Color fundus photograph: 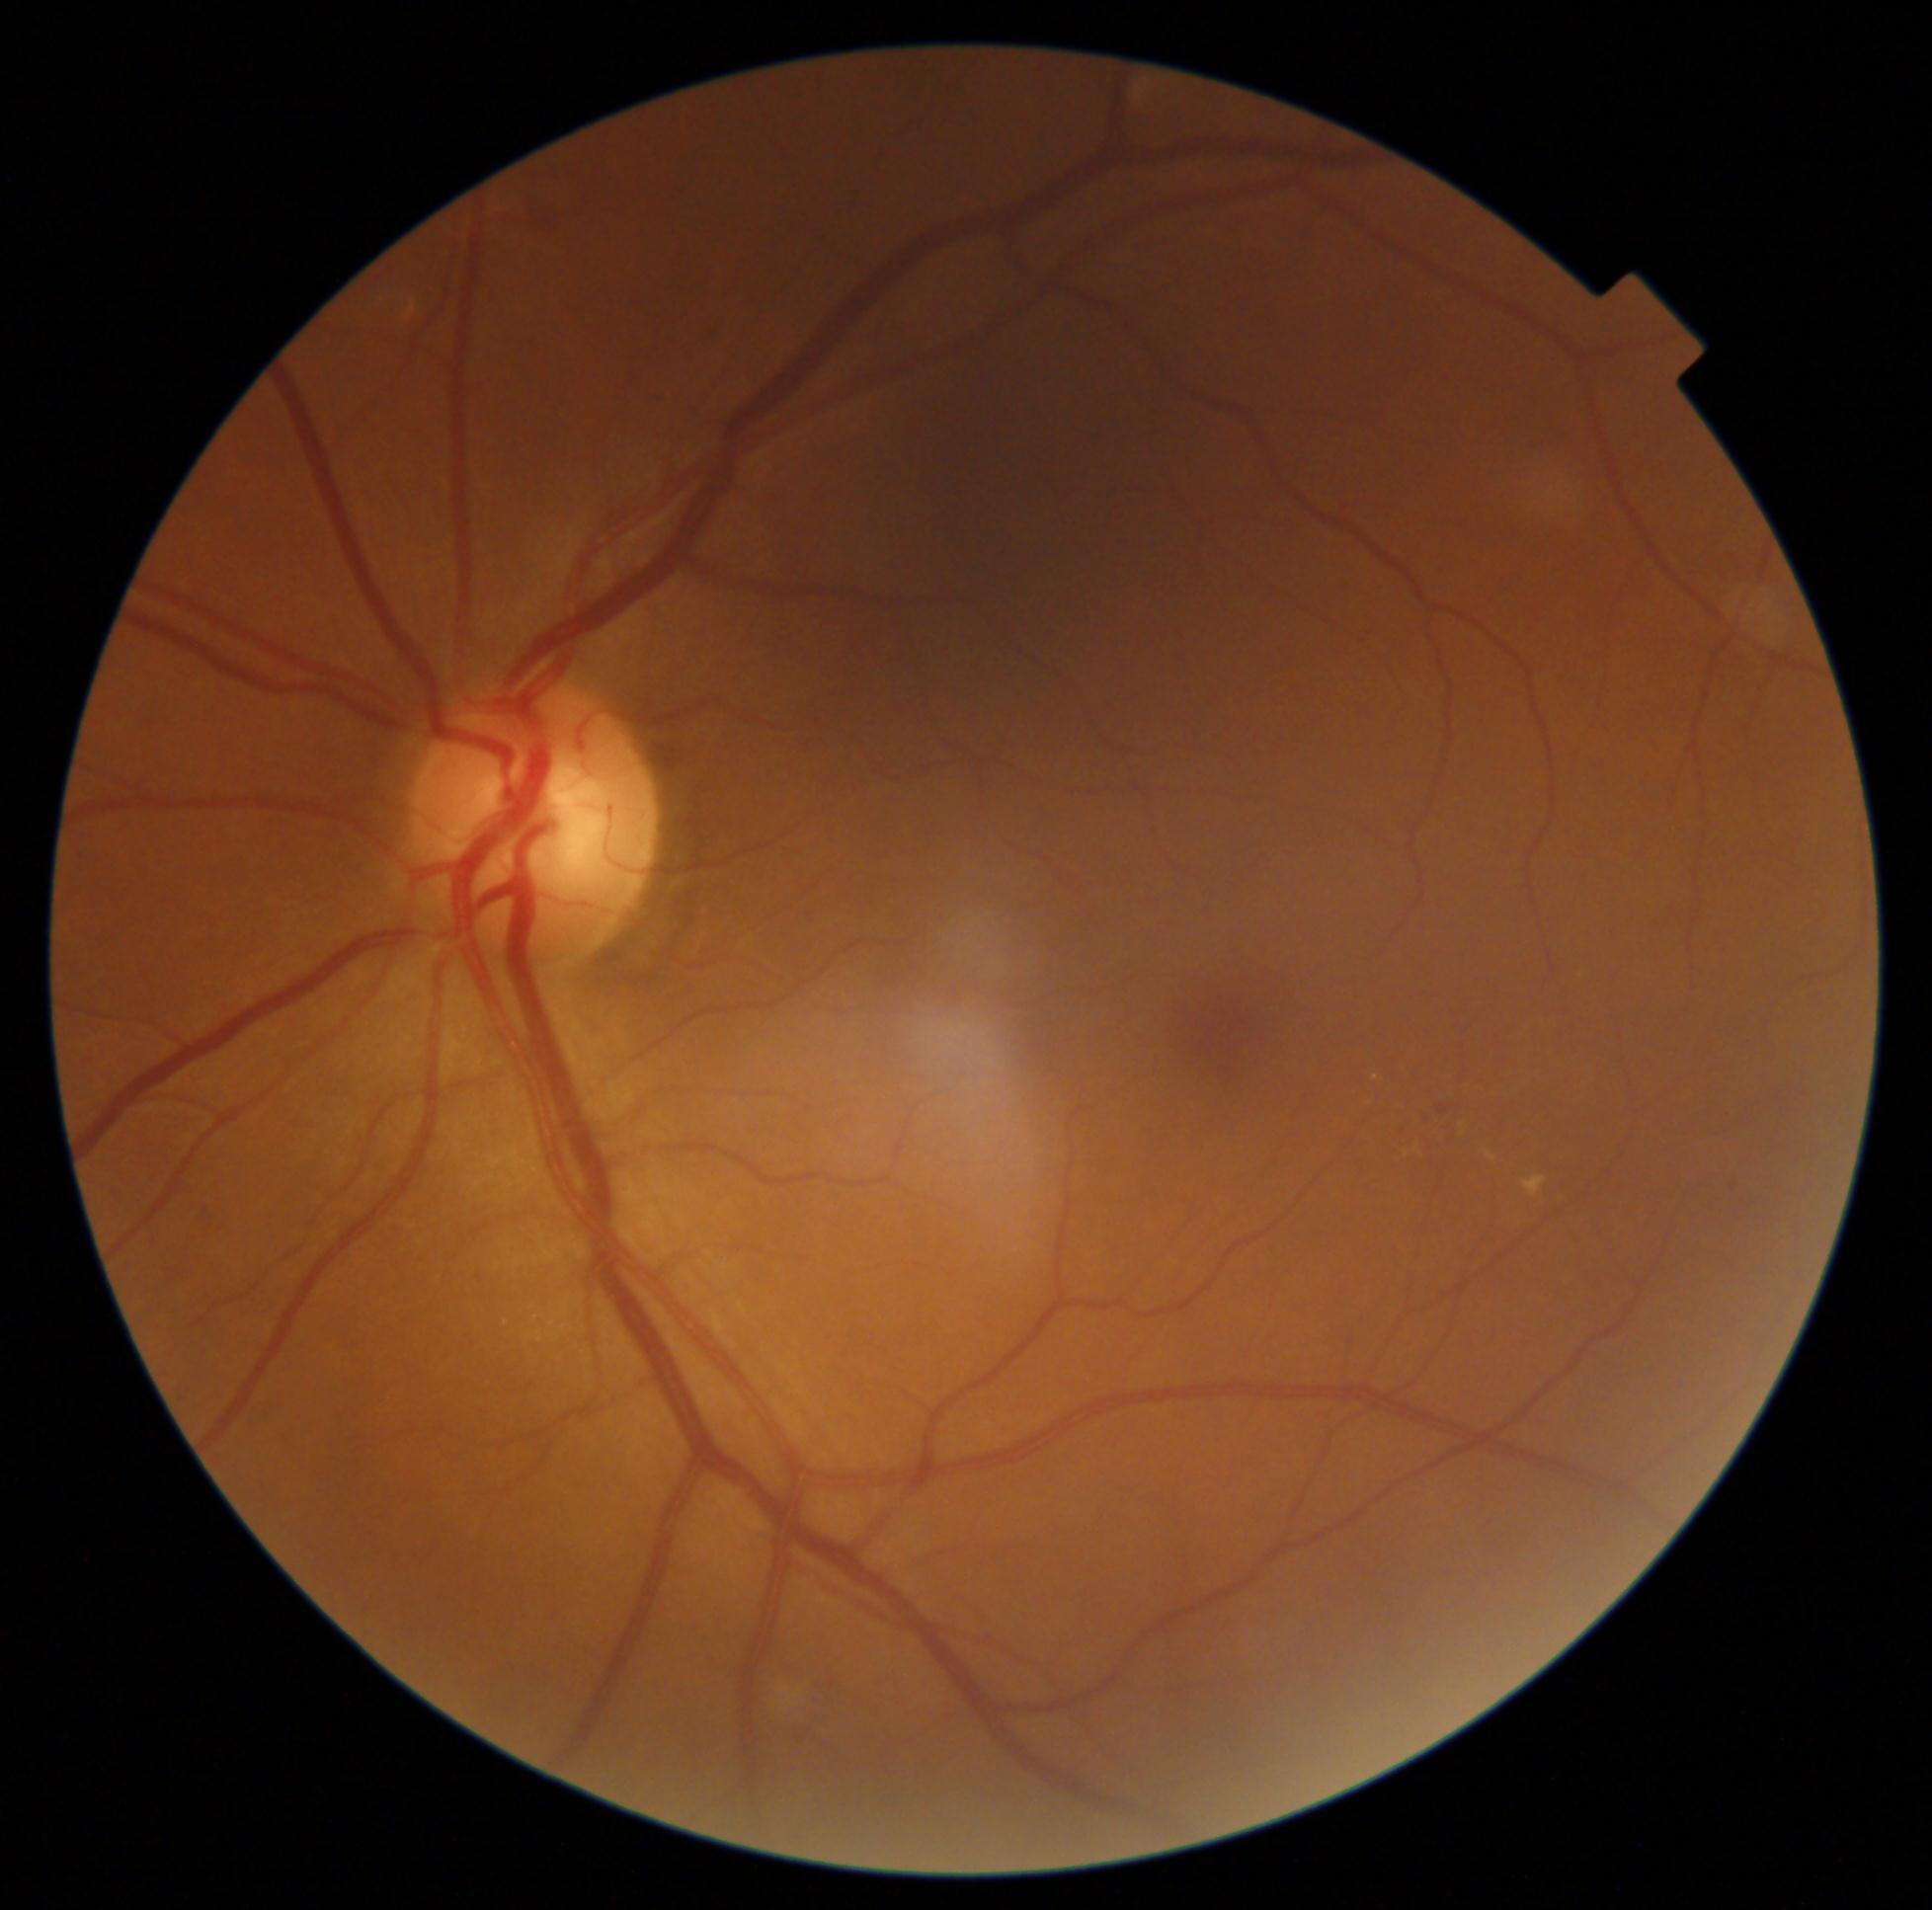 {"partial": true, "dr_grade": 2, "dr_grade_name": "moderate NPDR", "lesions": {"he": null, "se": null, "ex": [[1523, 1175, 1548, 1197], [1460, 1118, 1468, 1136], [1412, 1138, 1422, 1157], [1486, 1151, 1497, 1161]], "ex_small": [[1376, 1077], [1407, 1154]], "ma": [[1396, 1122, 1409, 1129], [1426, 1115, 1437, 1124], [1437, 1104, 1450, 1115]], "ma_small": [[1733, 1187]]}}